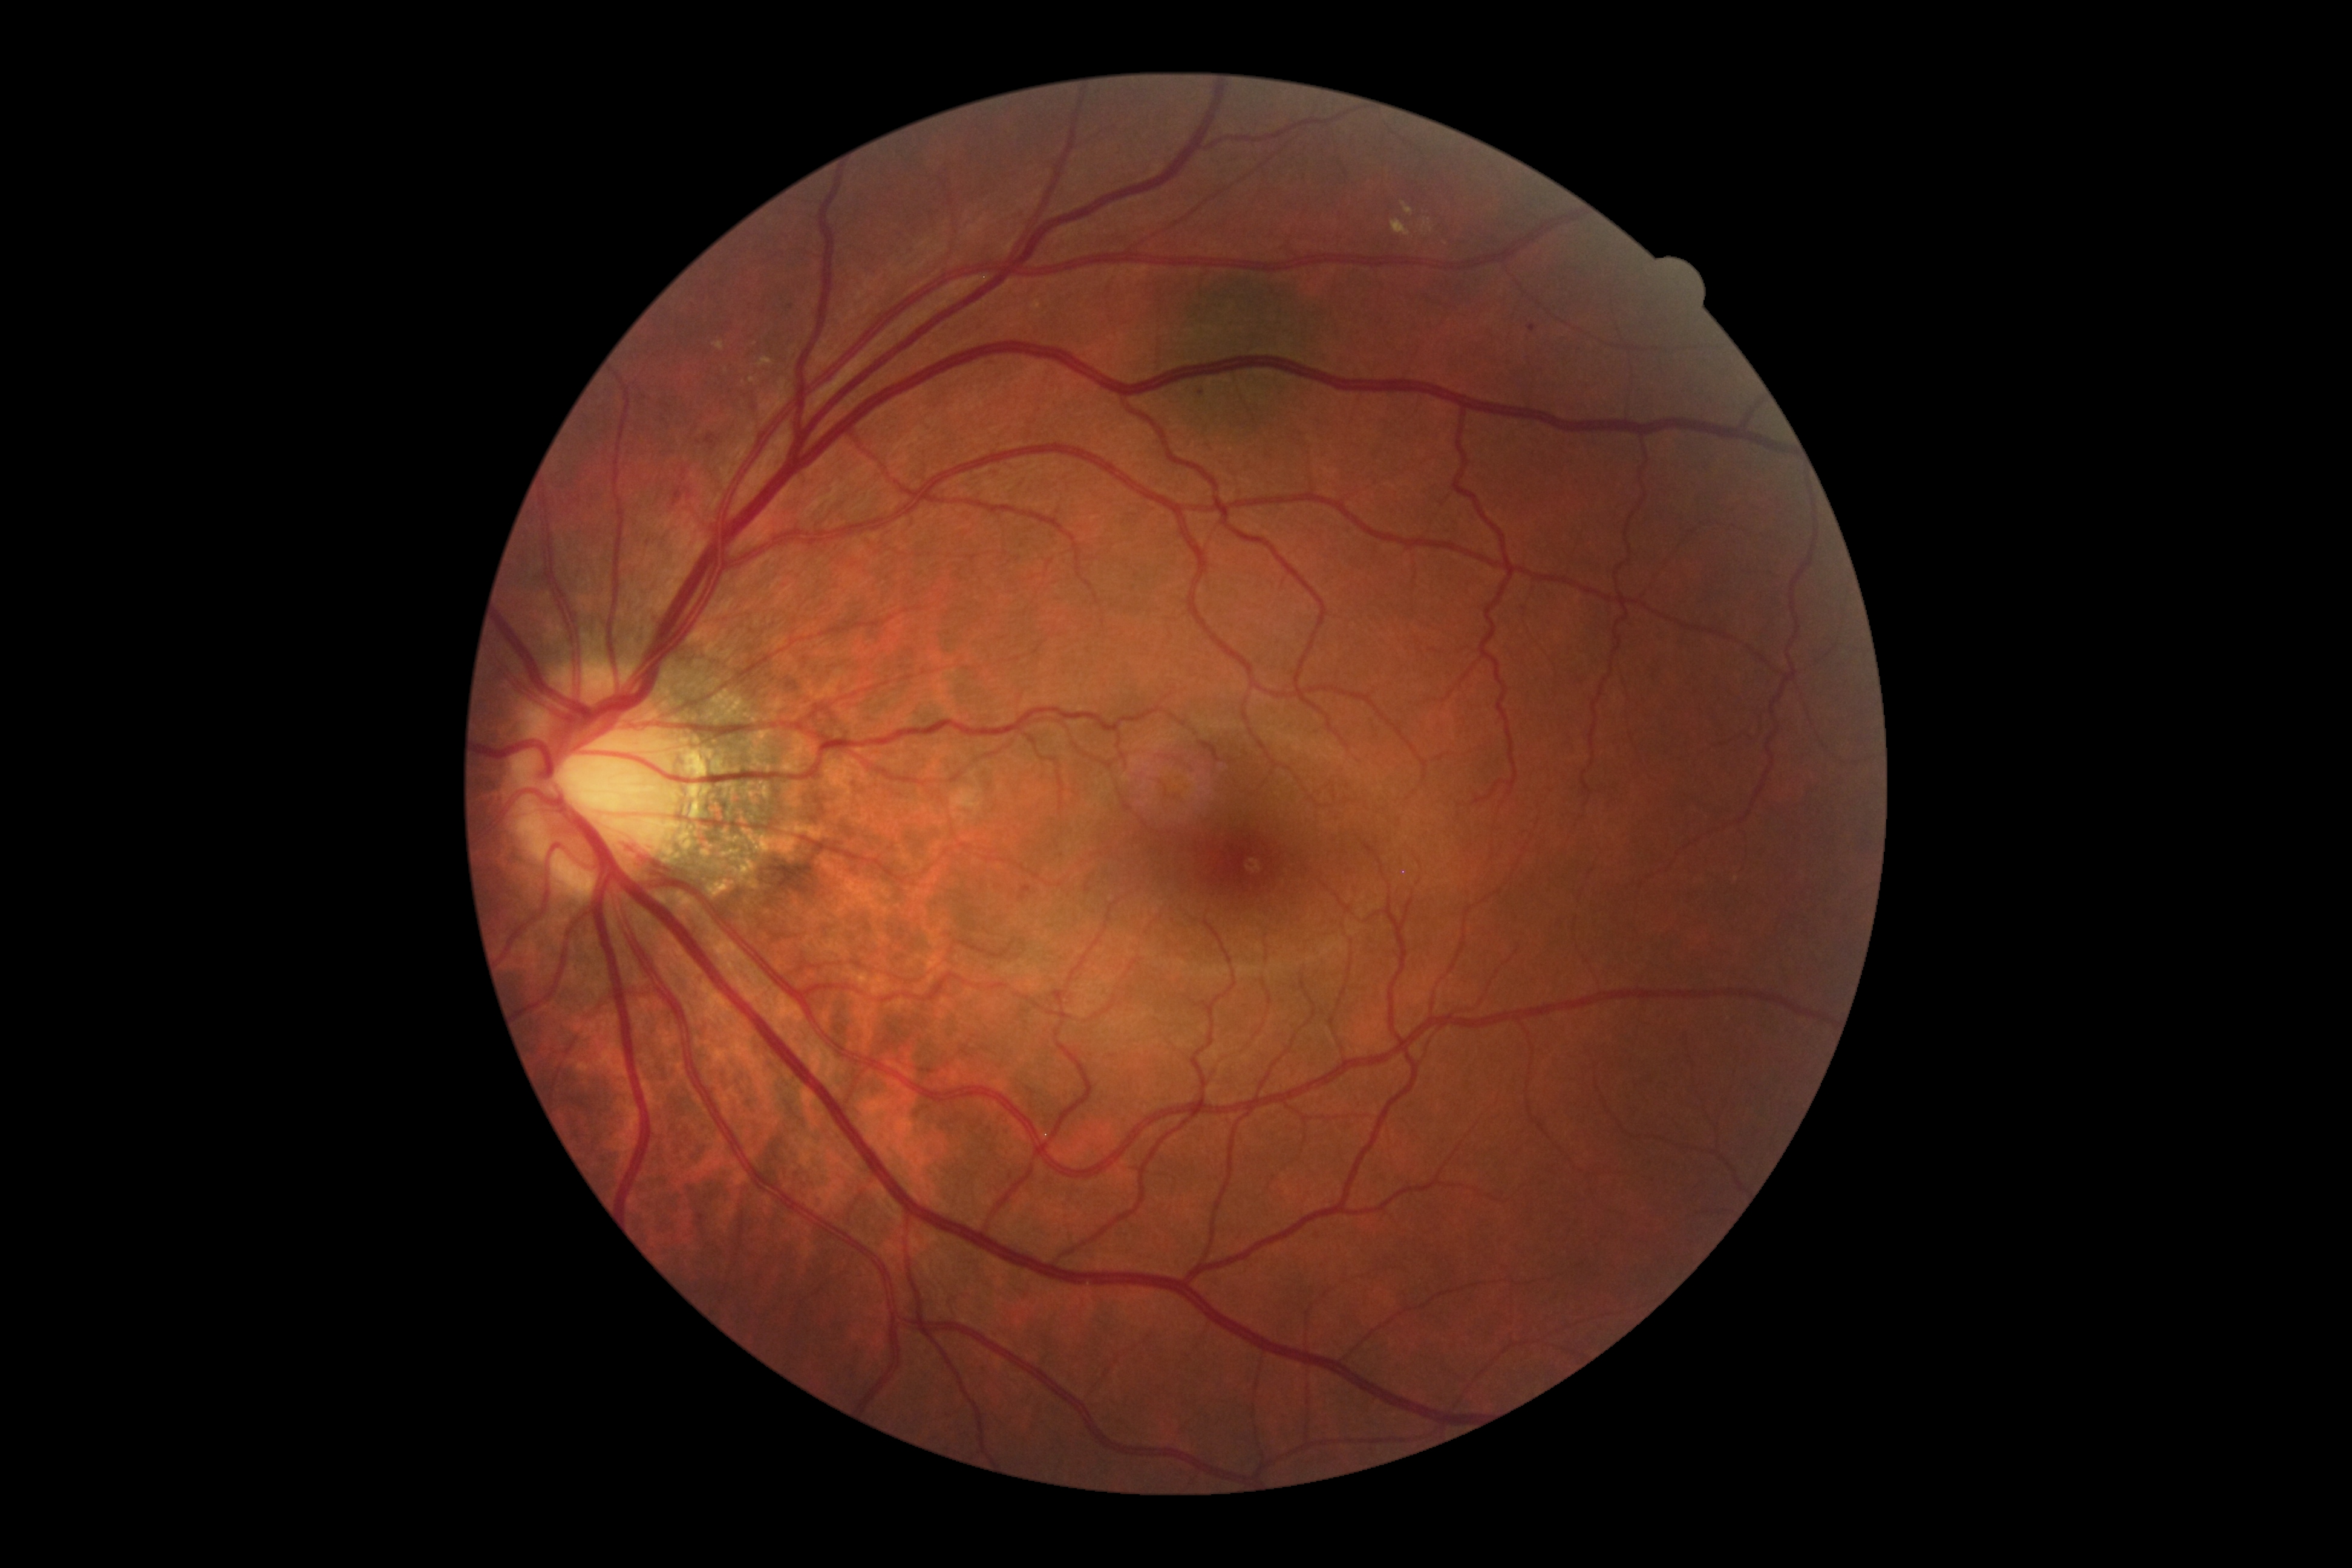

DR grade: 2.